Nonmydriatic
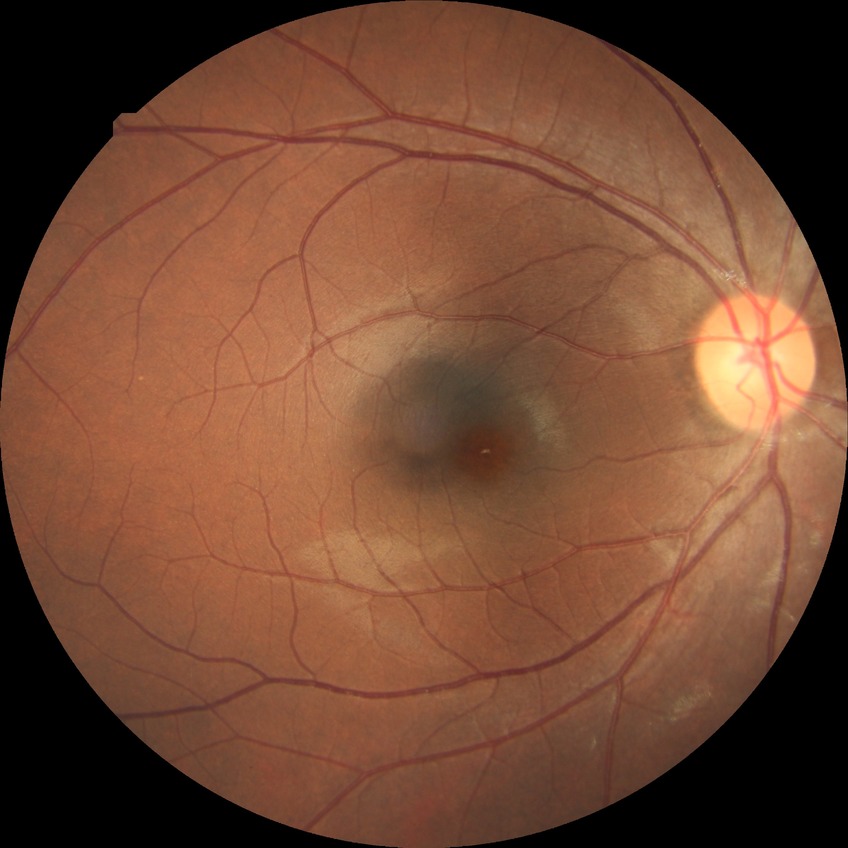
Davis stage: NDR.